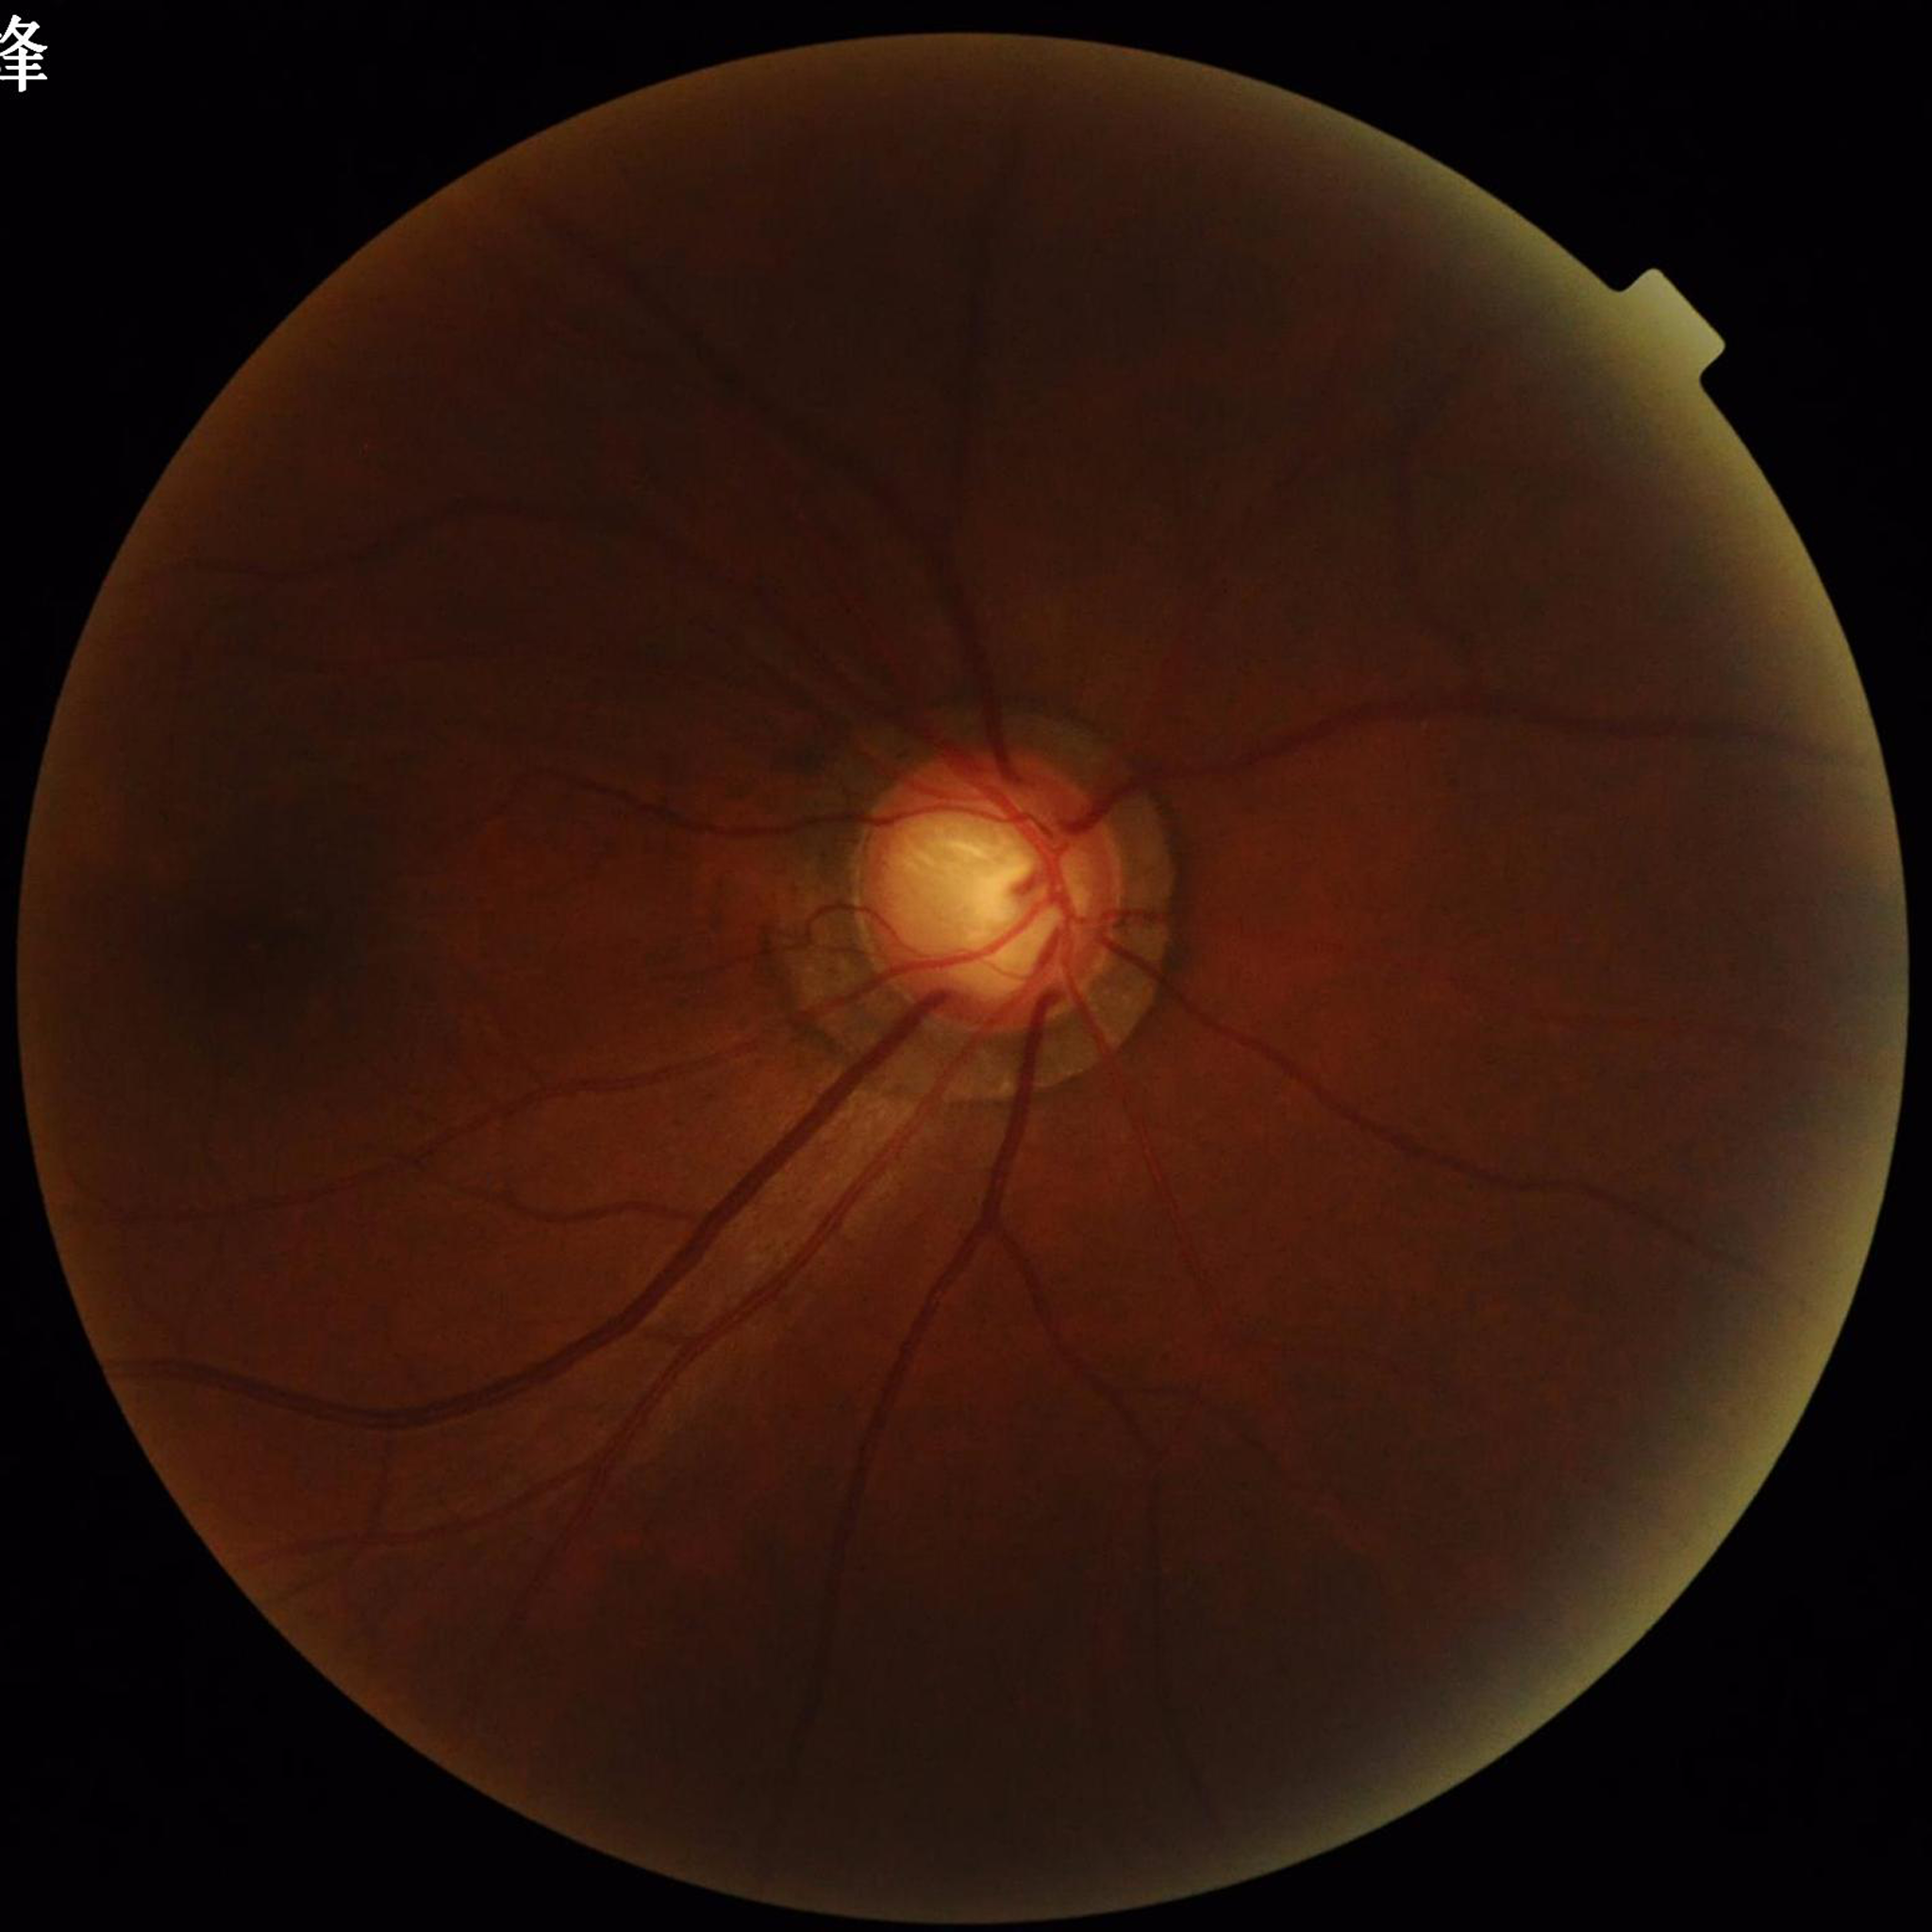
Impression: glaucoma | Quality: illumination/color distortion present, no blur, contrast adequate.